Color fundus image · 848 x 848 pixels:
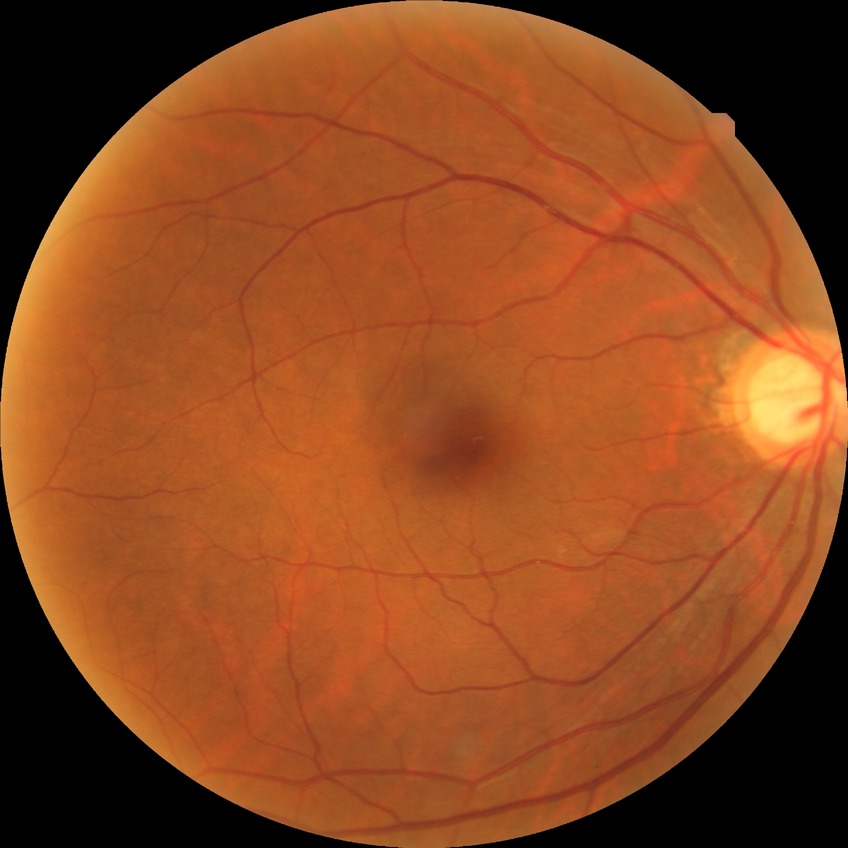 diabetic retinopathy (DR)@NDR (no diabetic retinopathy).